1440 x 1080 pixels. Pediatric retinal photograph (wide-field). Acquired on the Natus RetCam Envision — 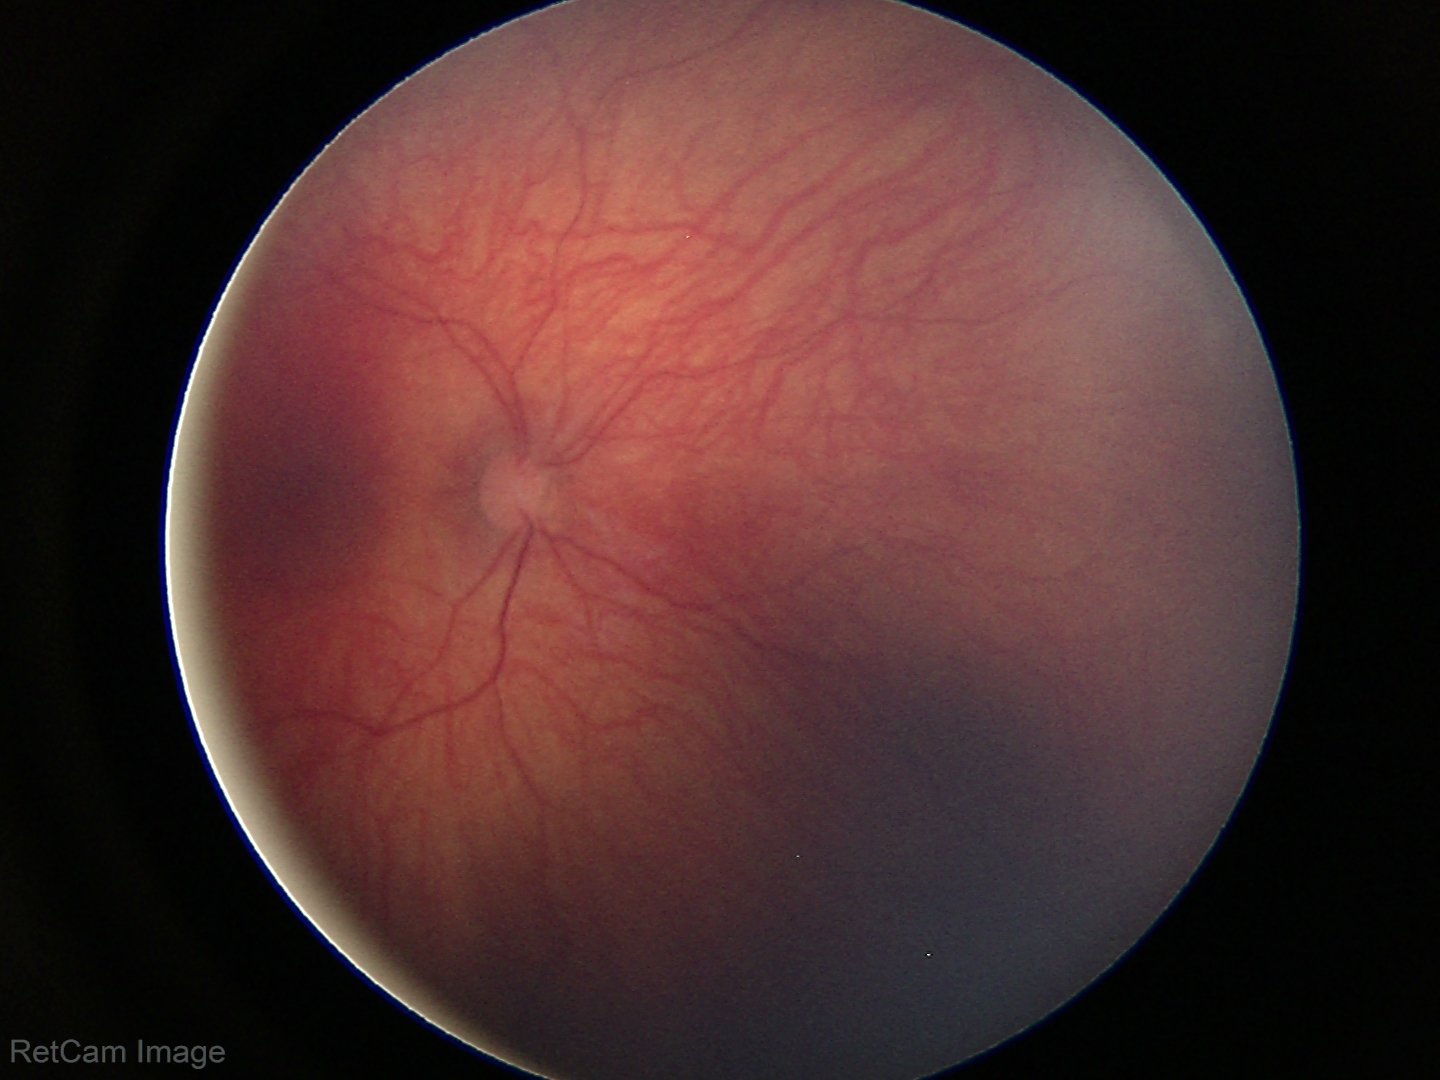 Screening examination diagnosed as physiological.